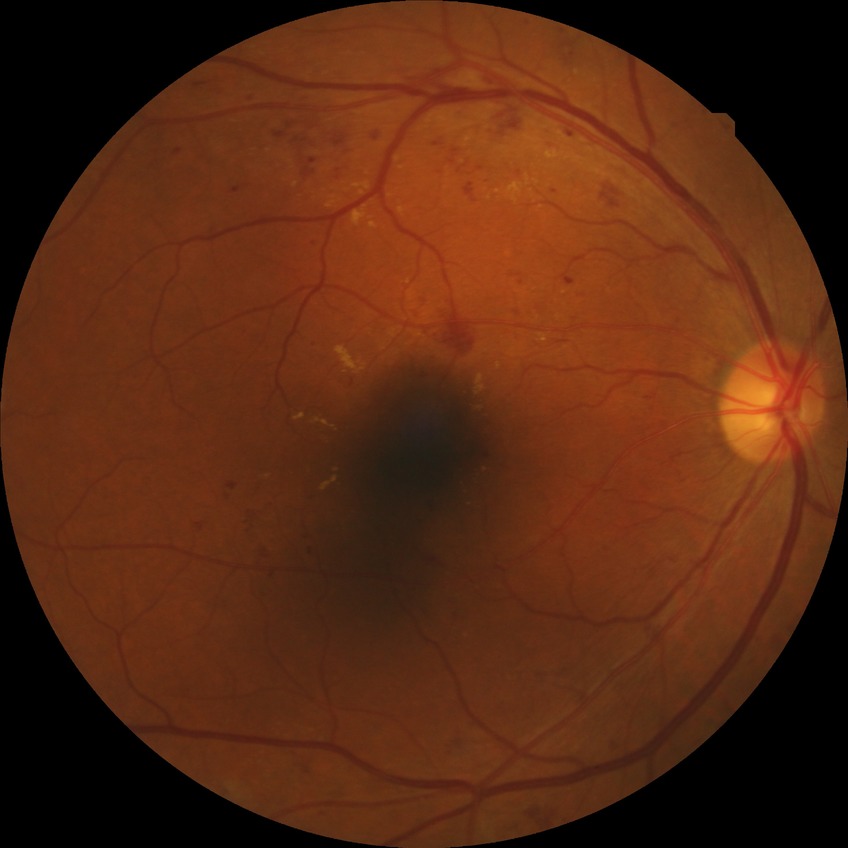

Diabetic retinopathy (DR) is SDR (simple diabetic retinopathy).